Wide-field fundus image from infant ROP screening: 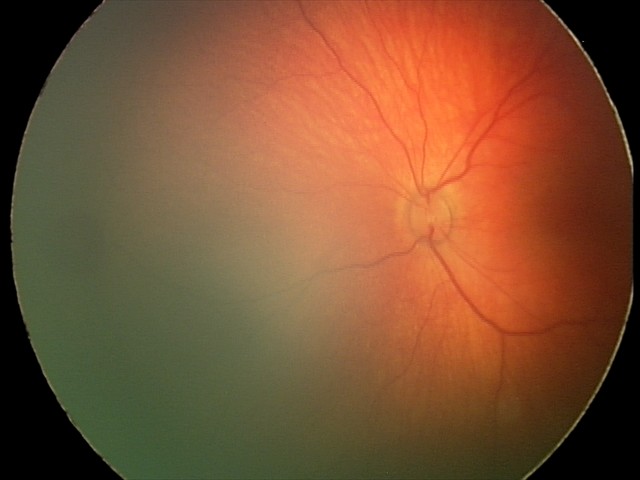 Assessment = retinal hemorrhages.